Color fundus image — 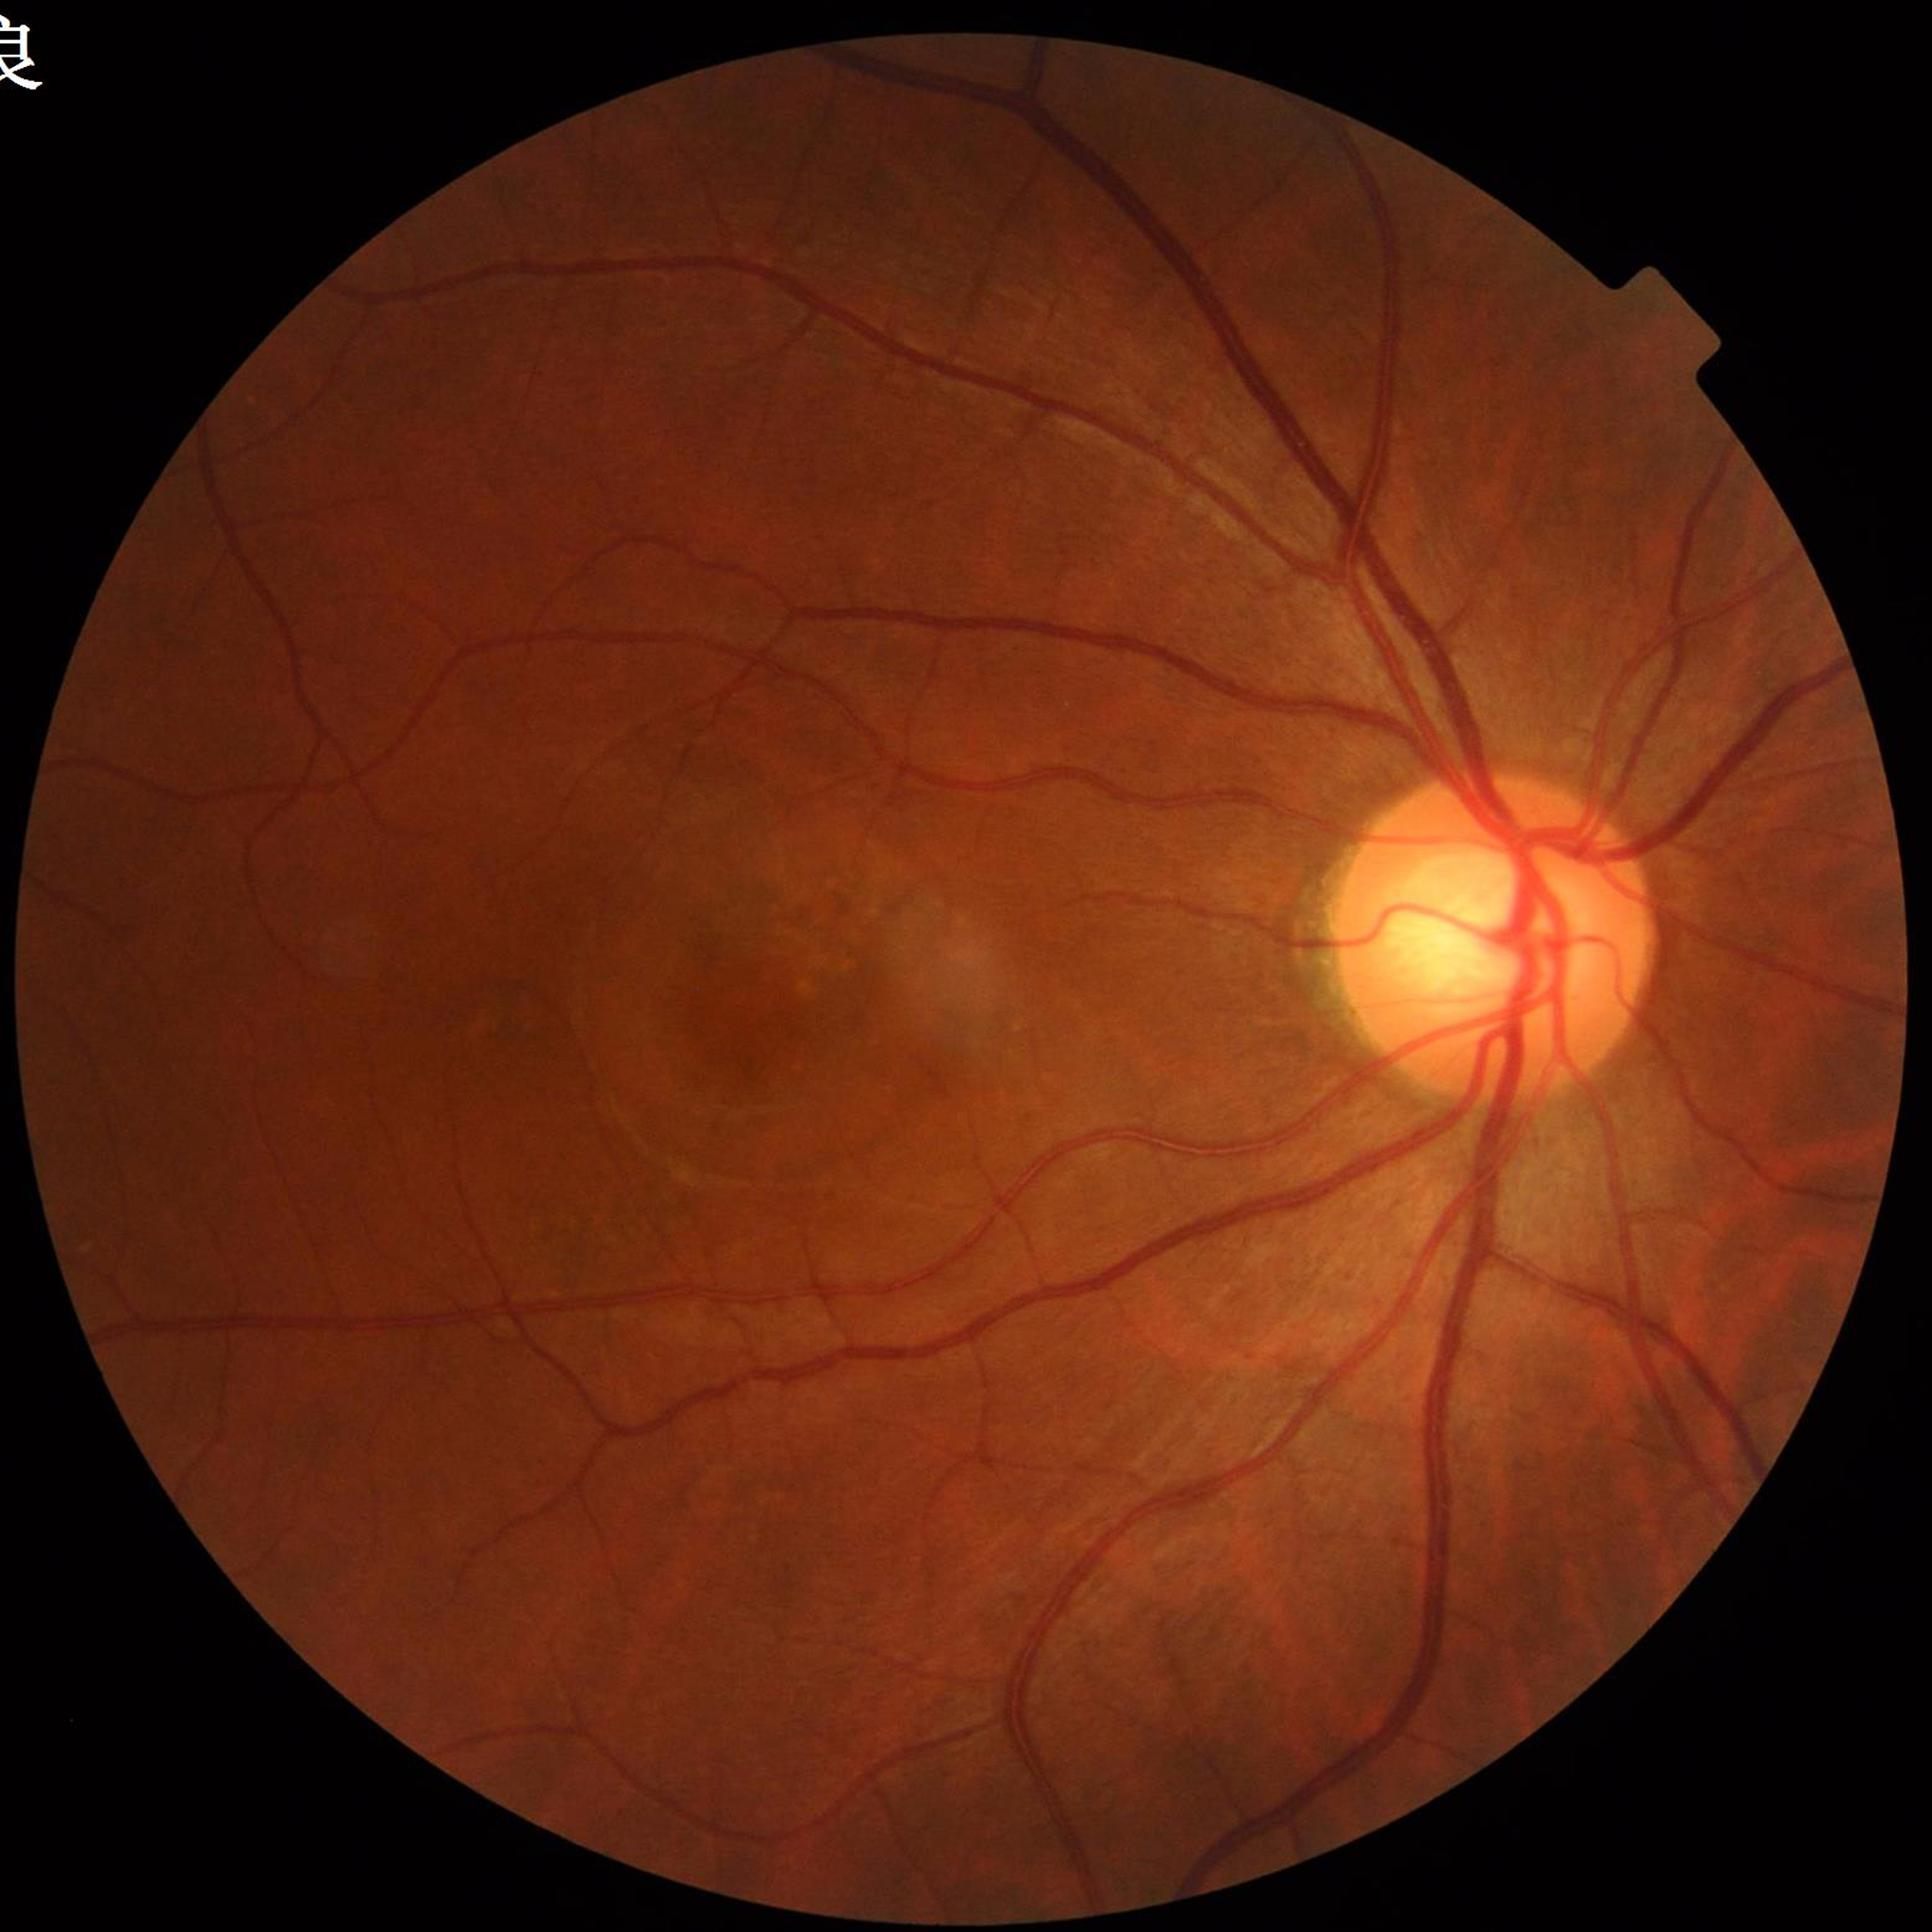
  diagnosis: AMD